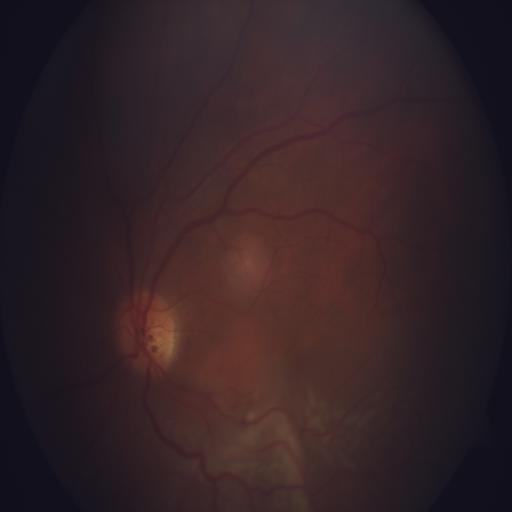 Color fundus photograph showing chorioretinitis.